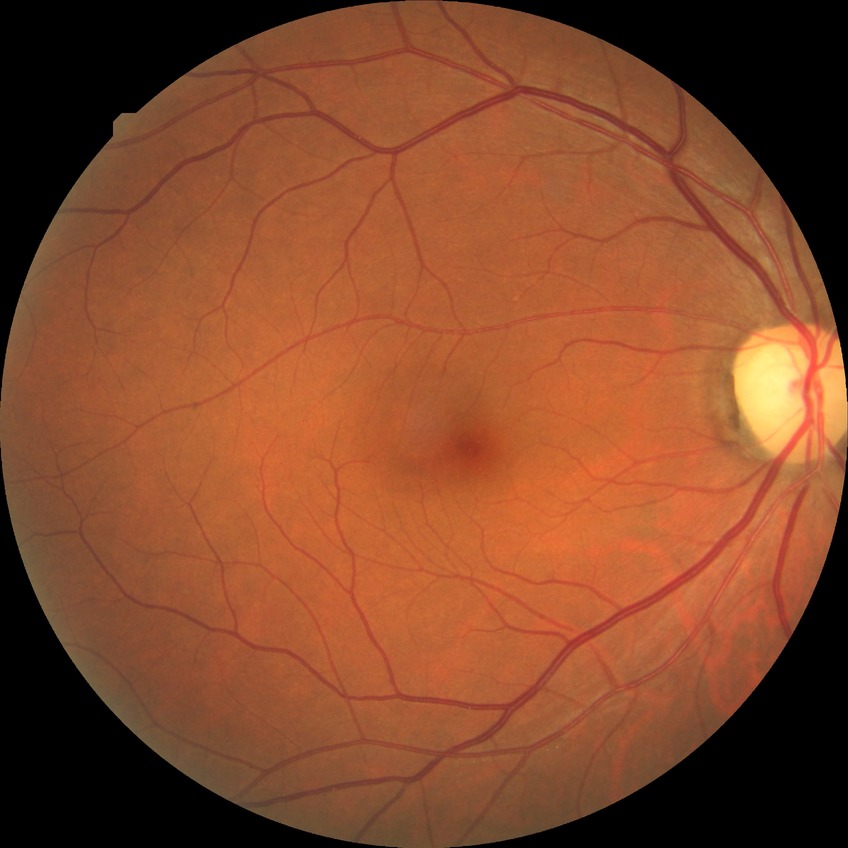
{"davis_grade": "no diabetic retinopathy (NDR)"}